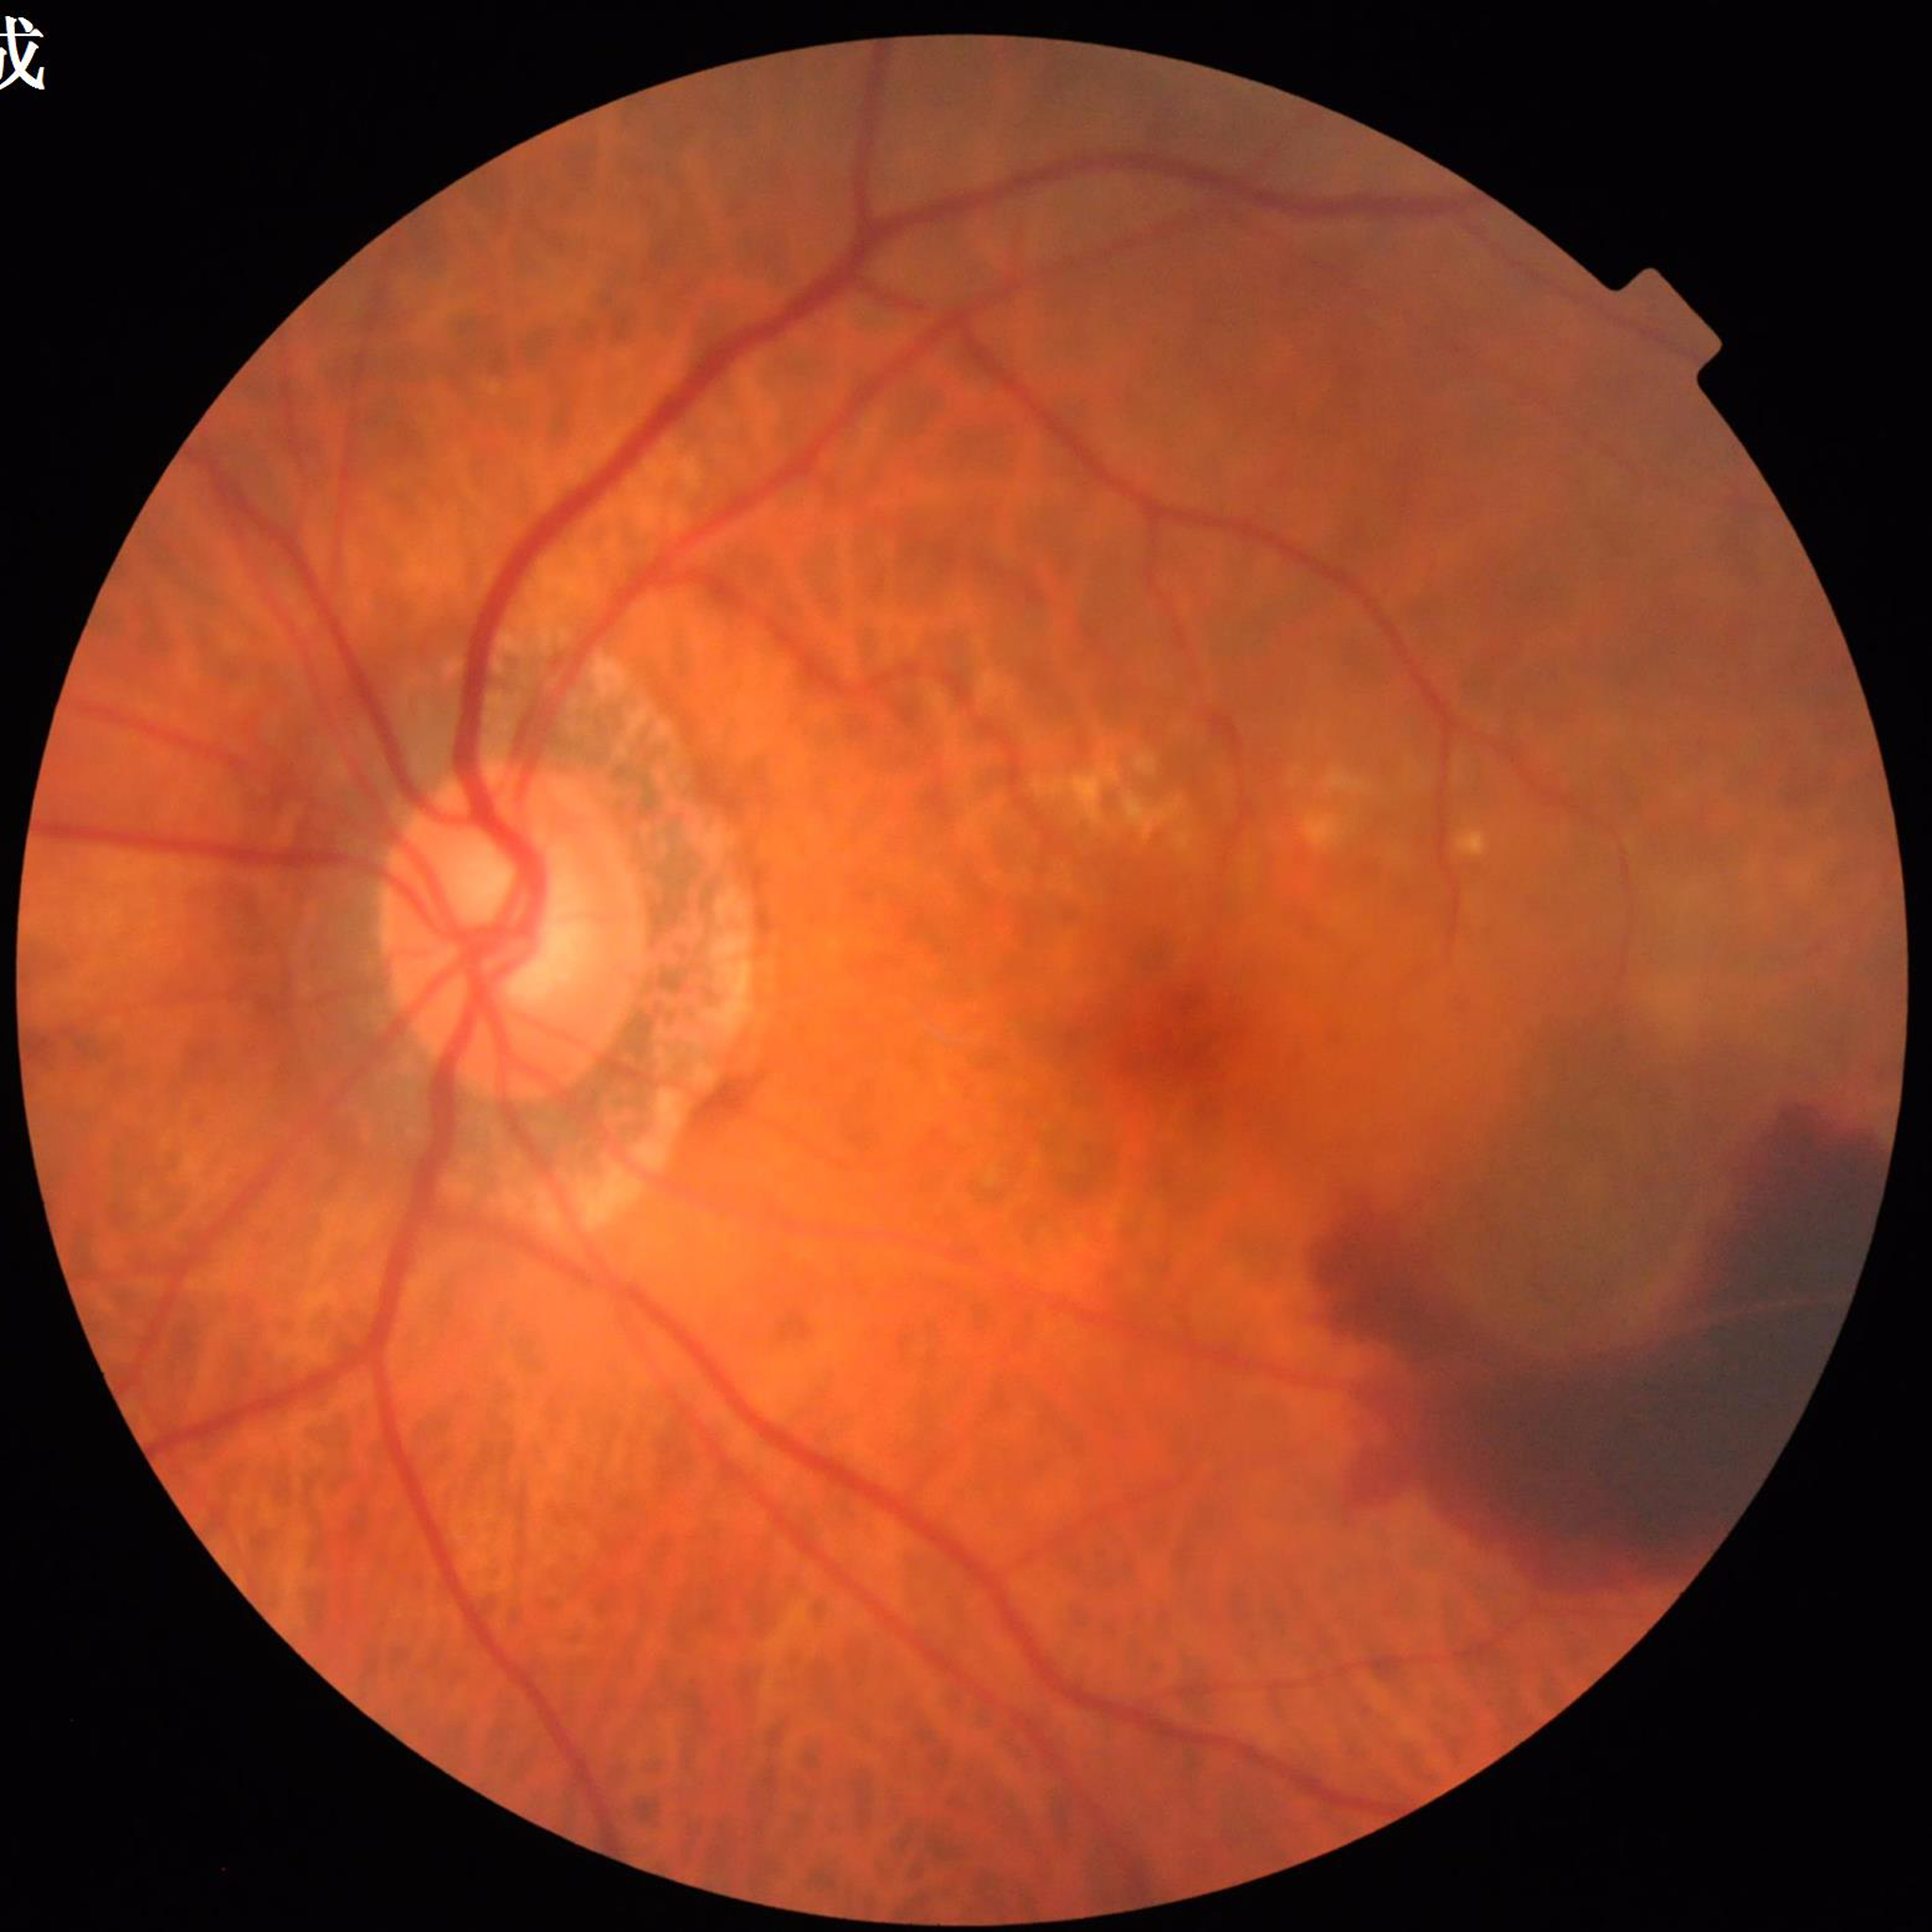

This fundus photograph is from a patient diagnosed with AMD. Automated quality assessment: adequate.